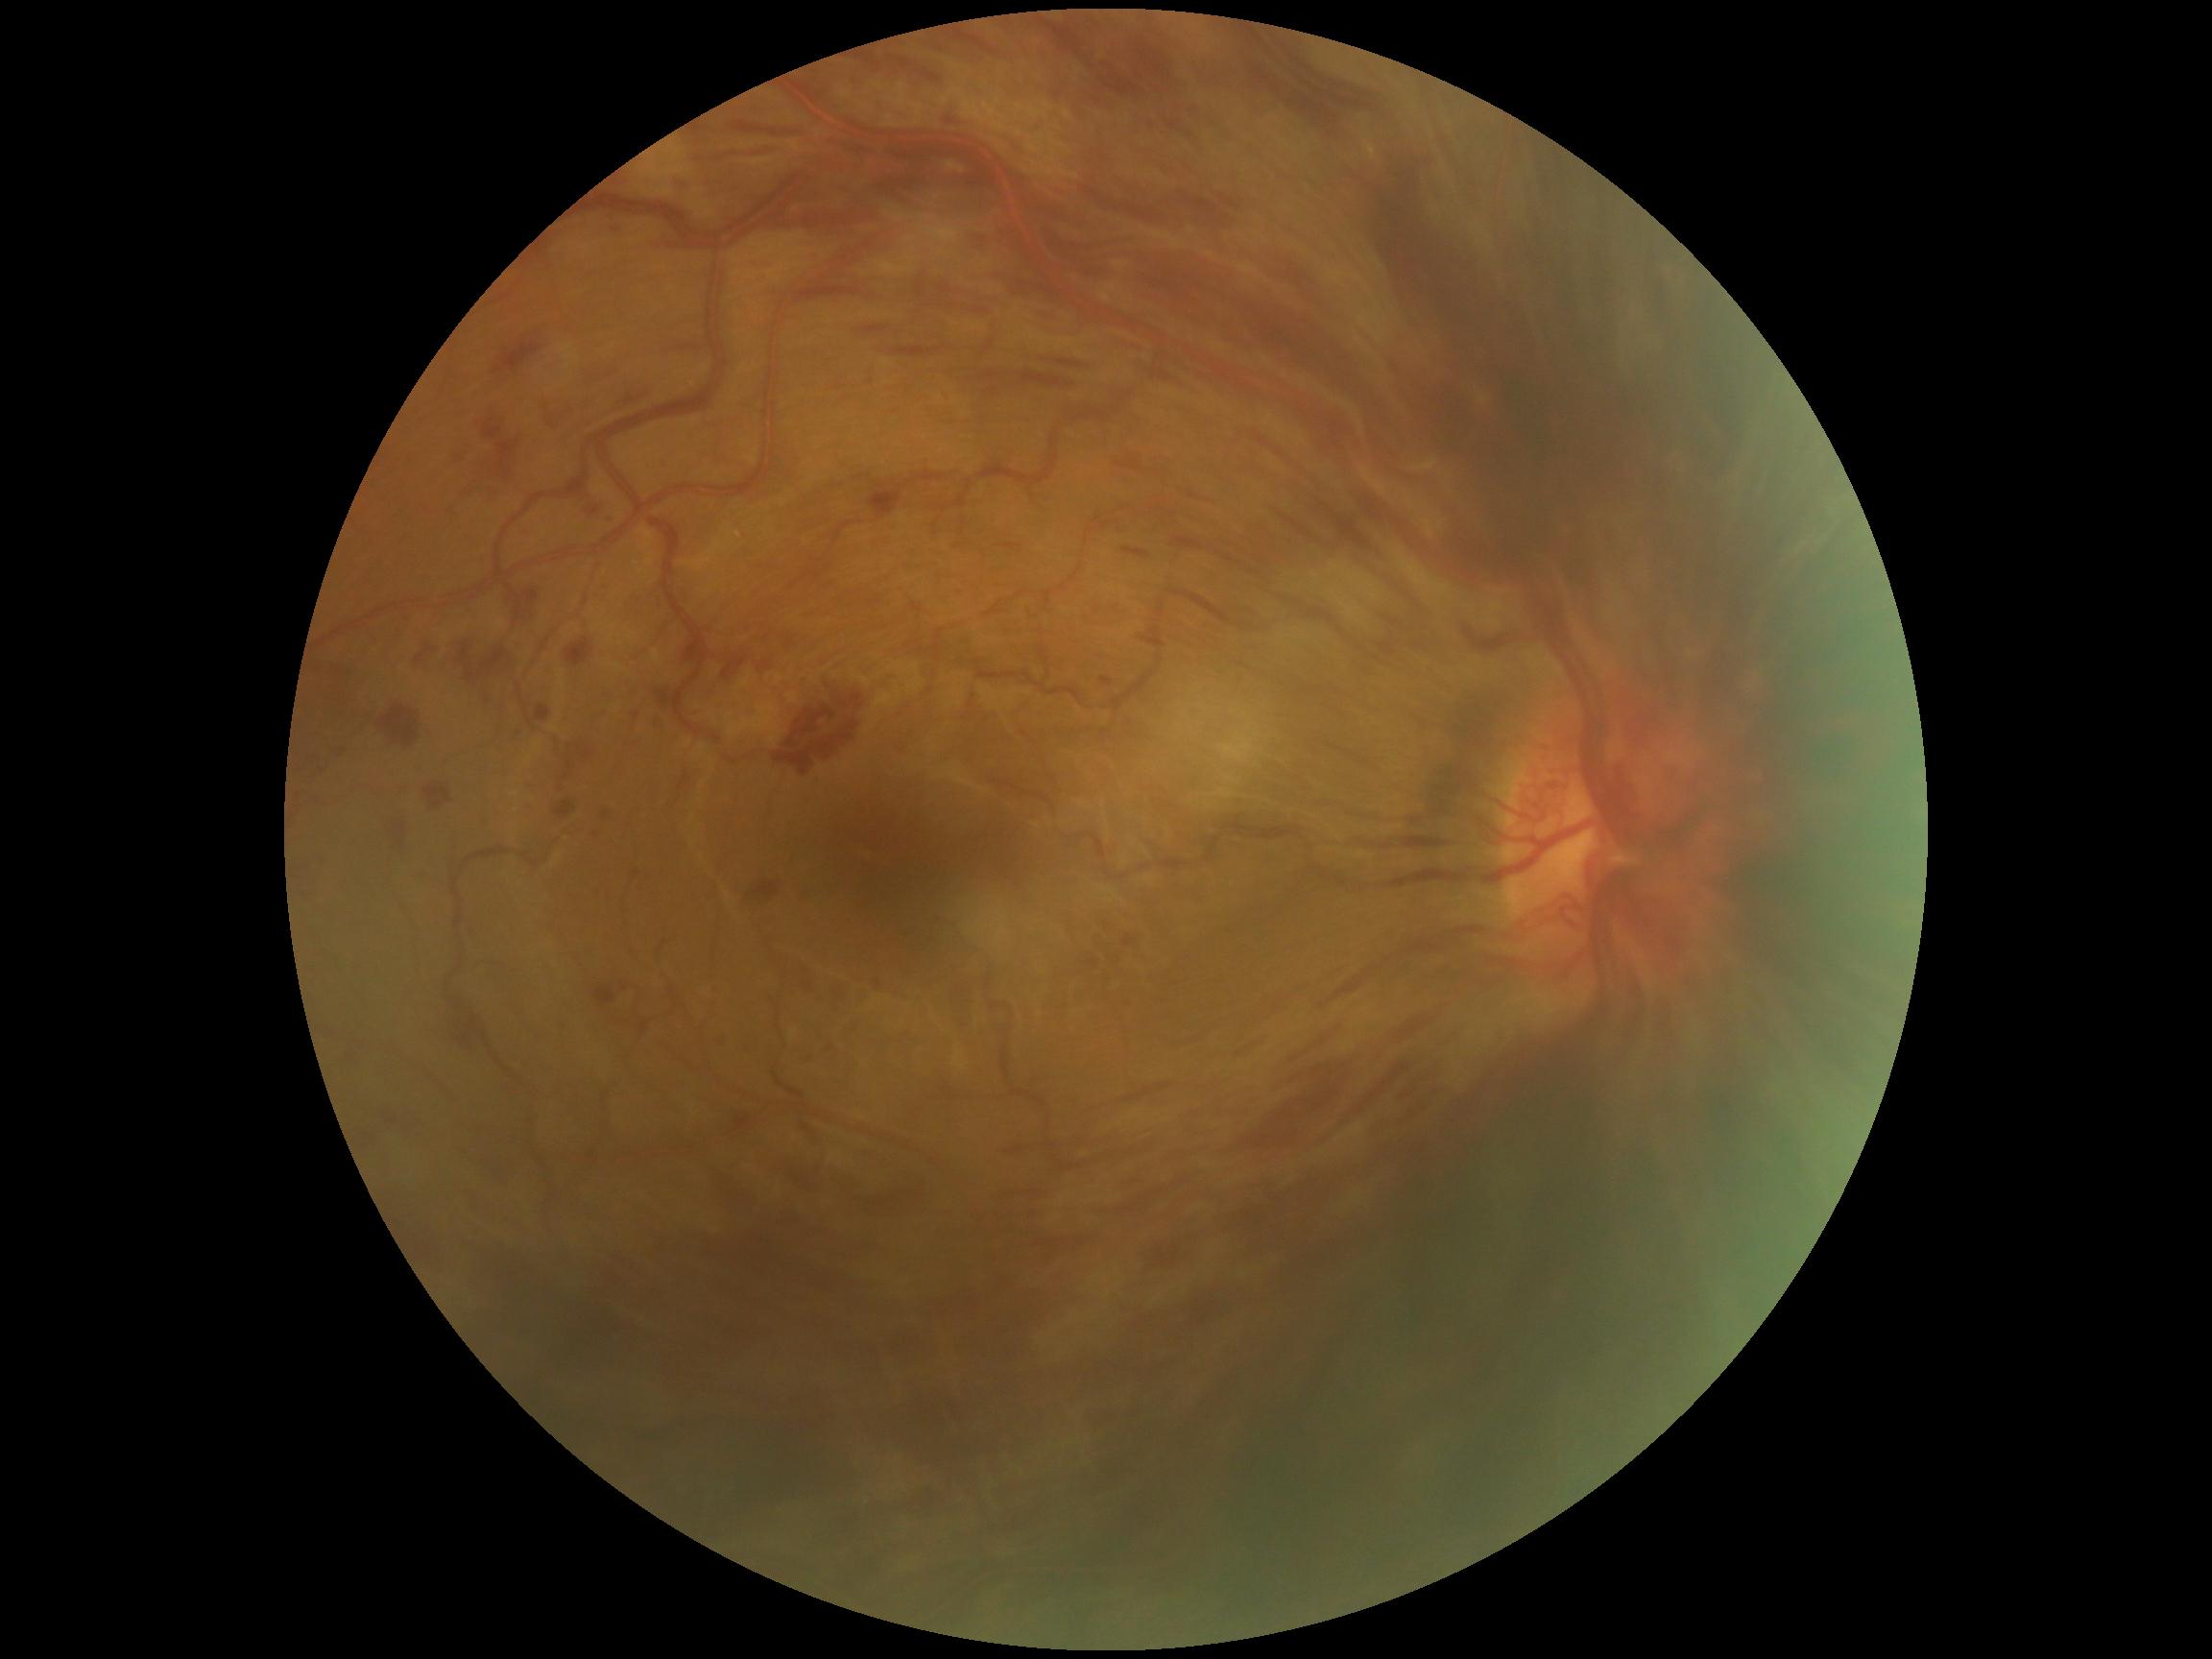 DR: grade 4 (PDR).